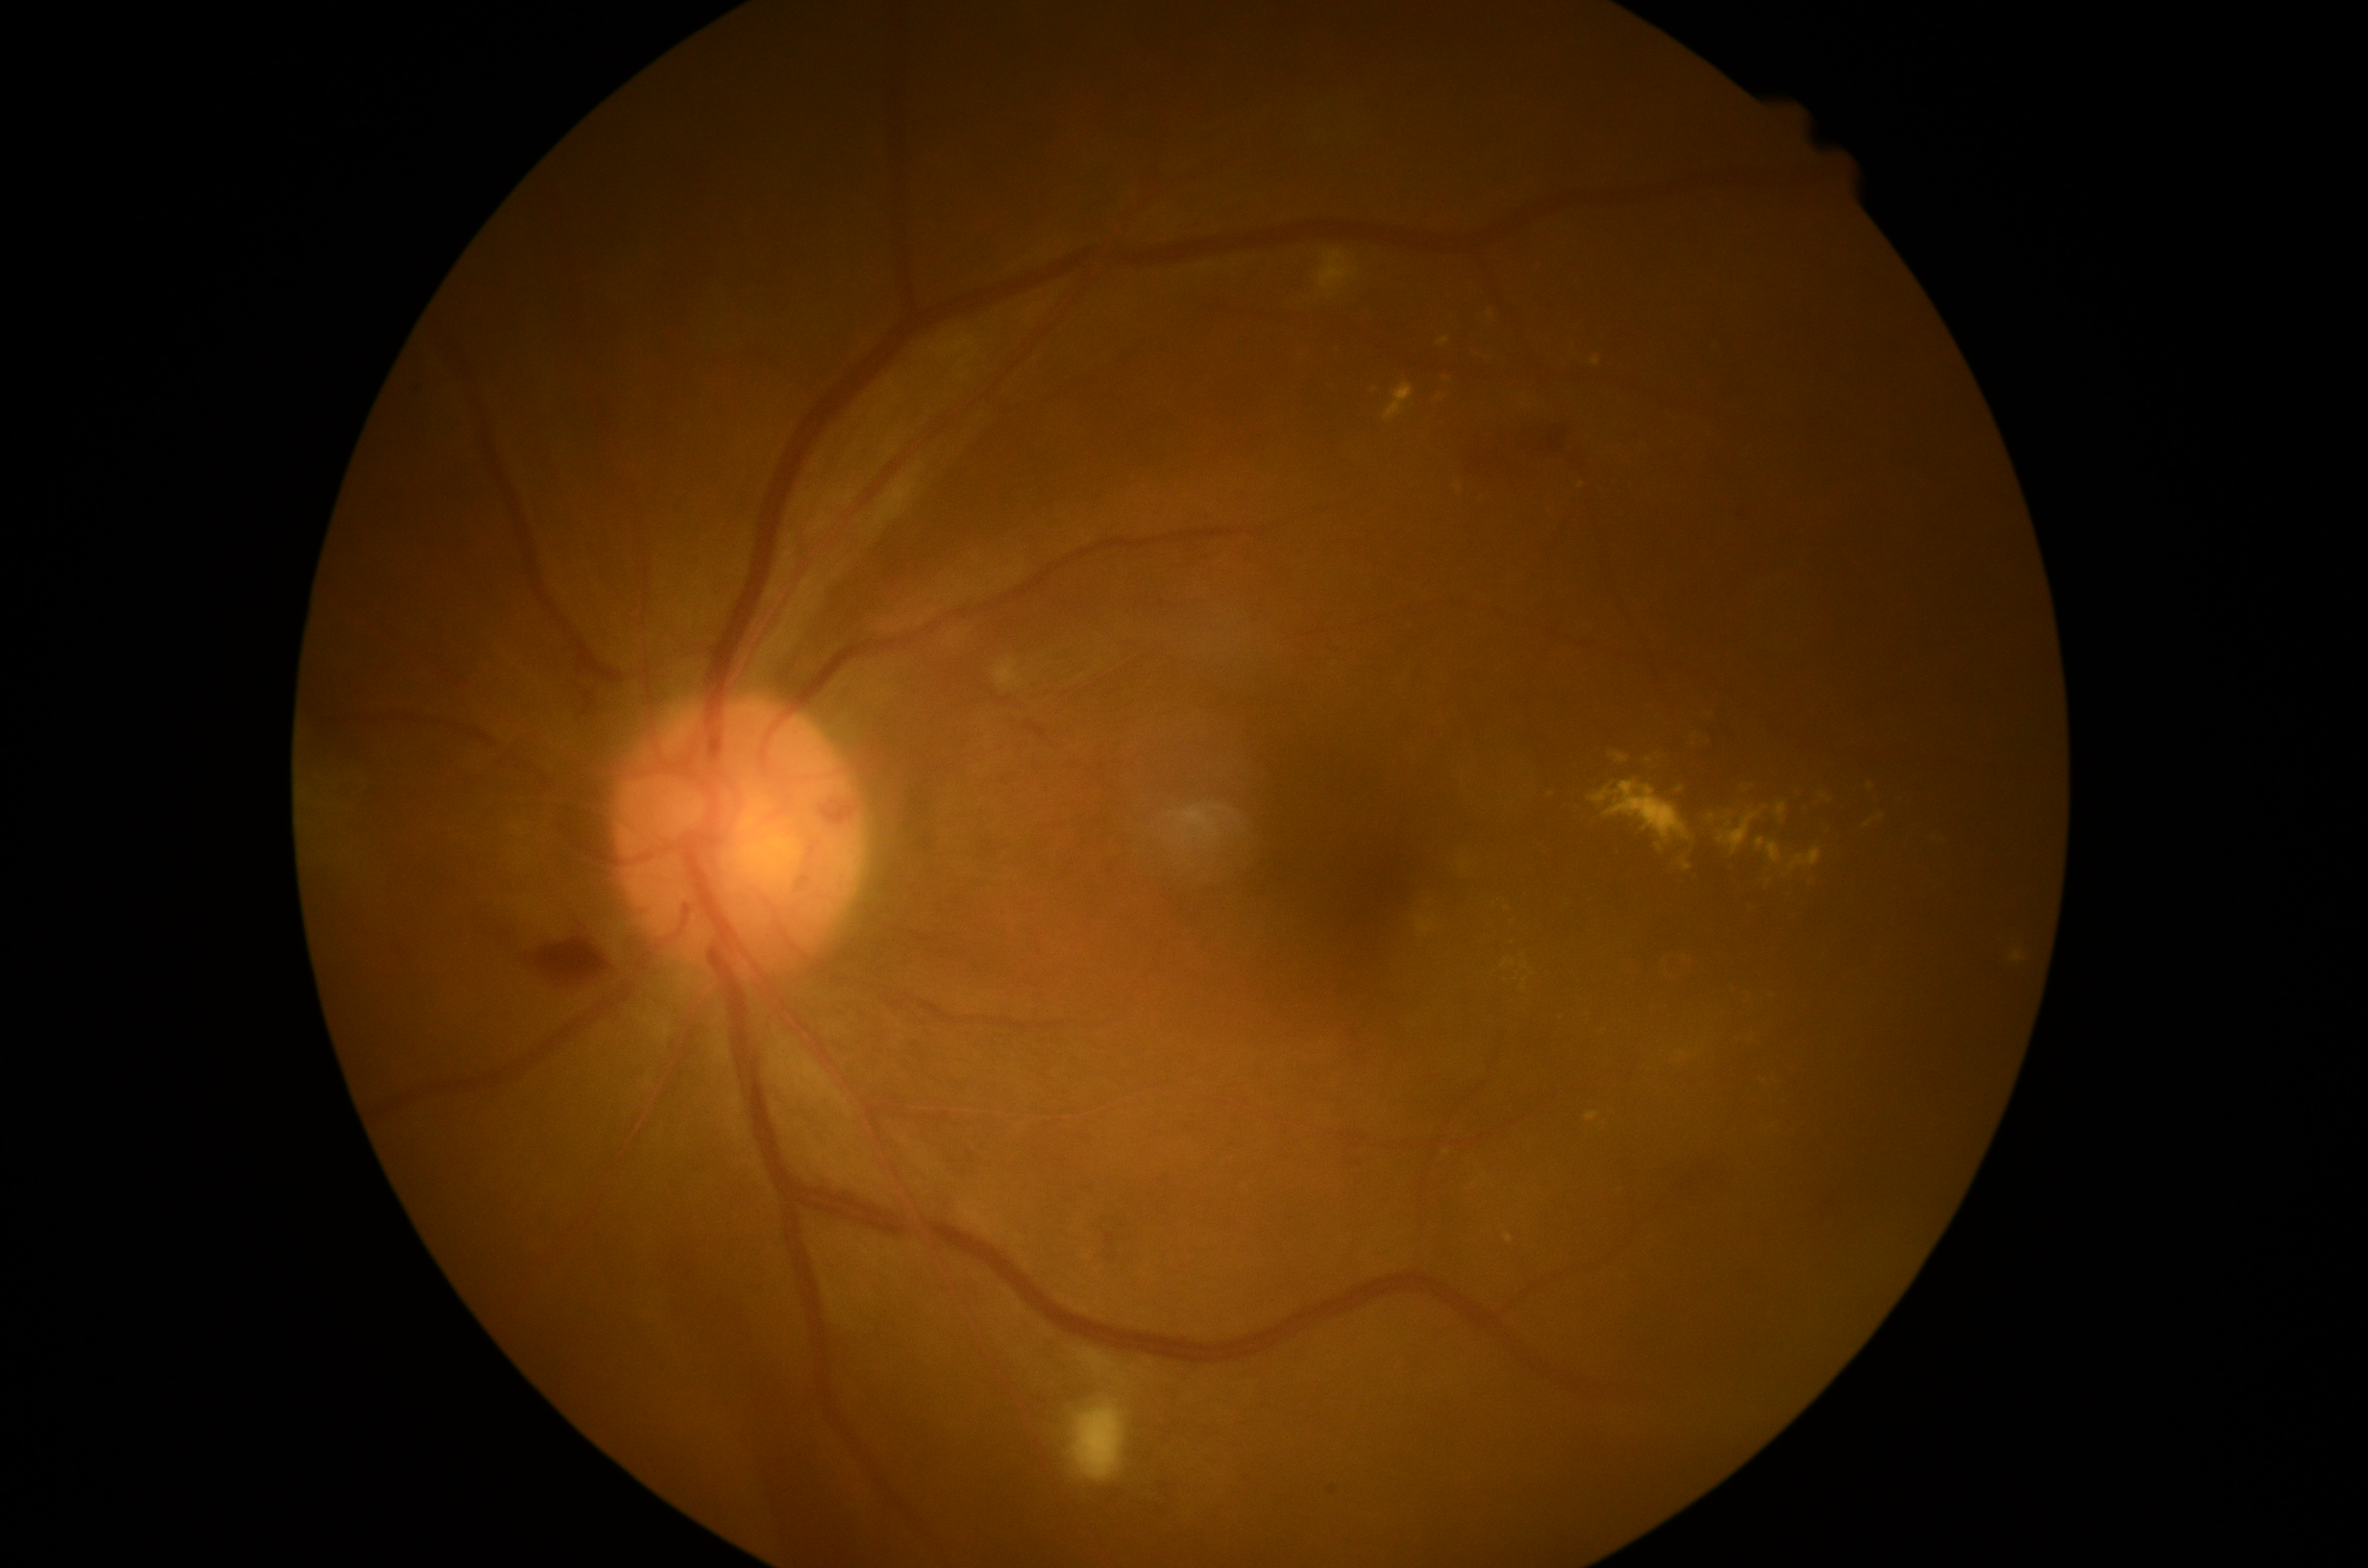 Findings:
• DR grade — moderate NPDR (2)
• DR class — non-proliferative diabetic retinopathy